Clarity RetCam 3, 130° FOV; 640x480px; RetCam wide-field infant fundus image — 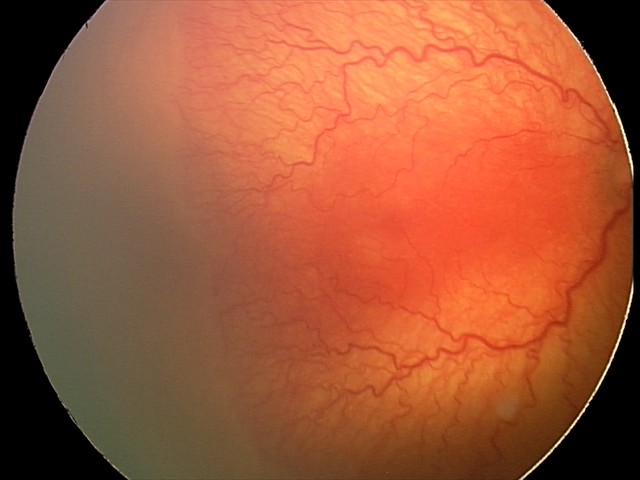 Series diagnosed as aggressive retinopathy of prematurity (A-ROP).